Wide-field fundus photograph of an infant · image size 1240x1240: 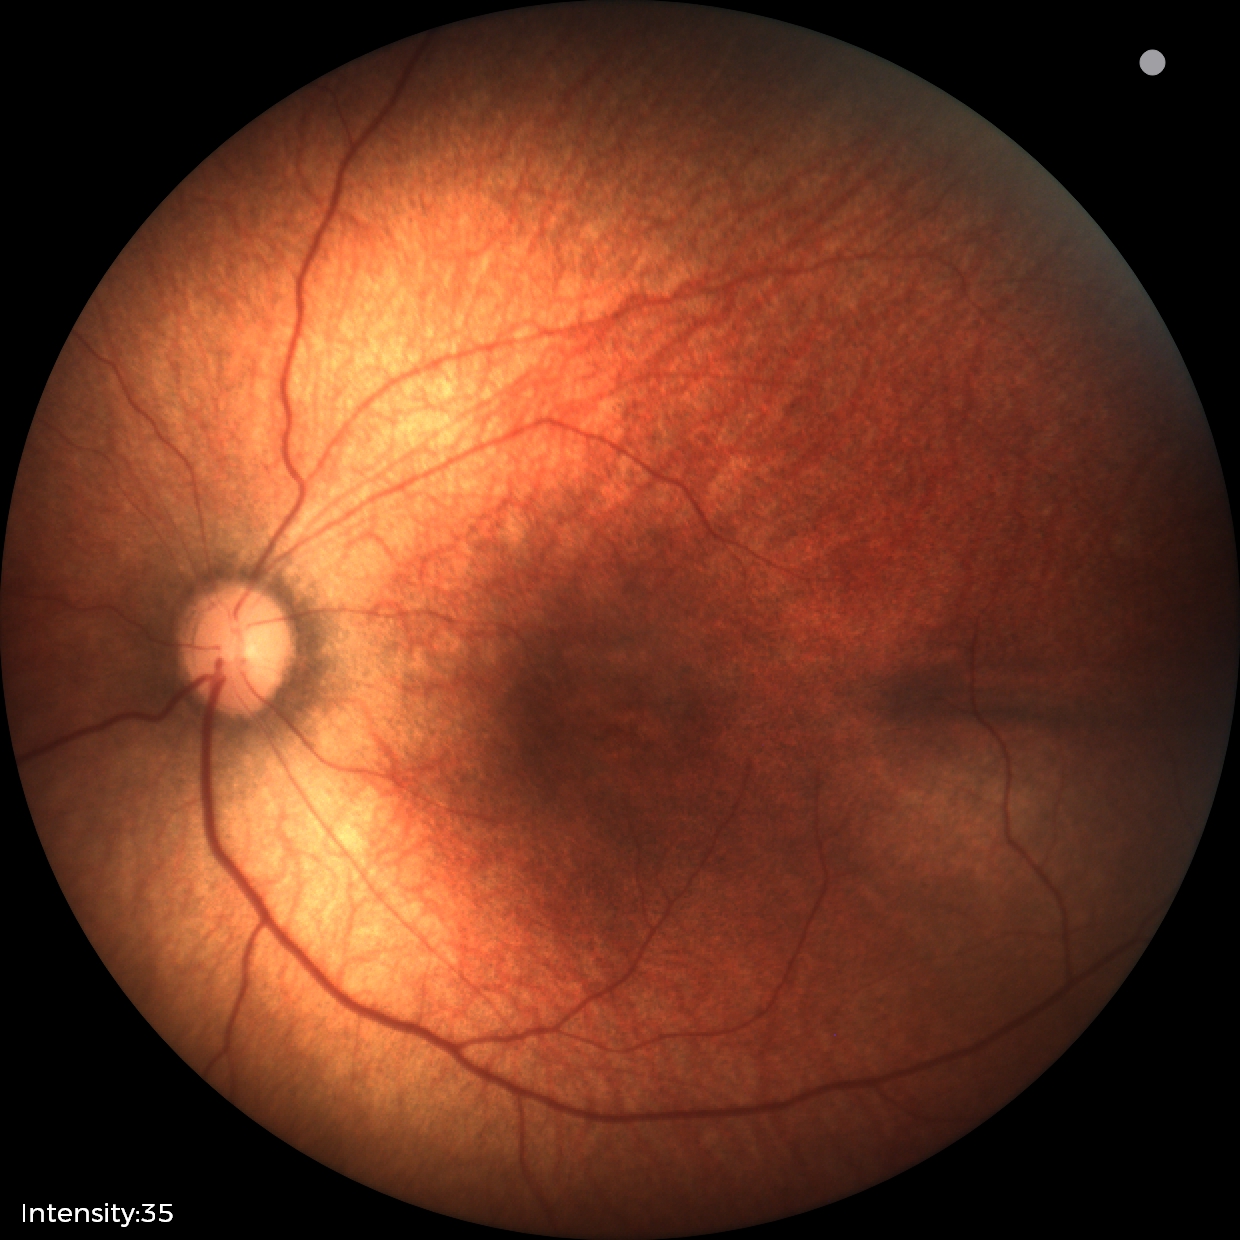

Normal screening examination.